1932x1916px, 45° FOV.
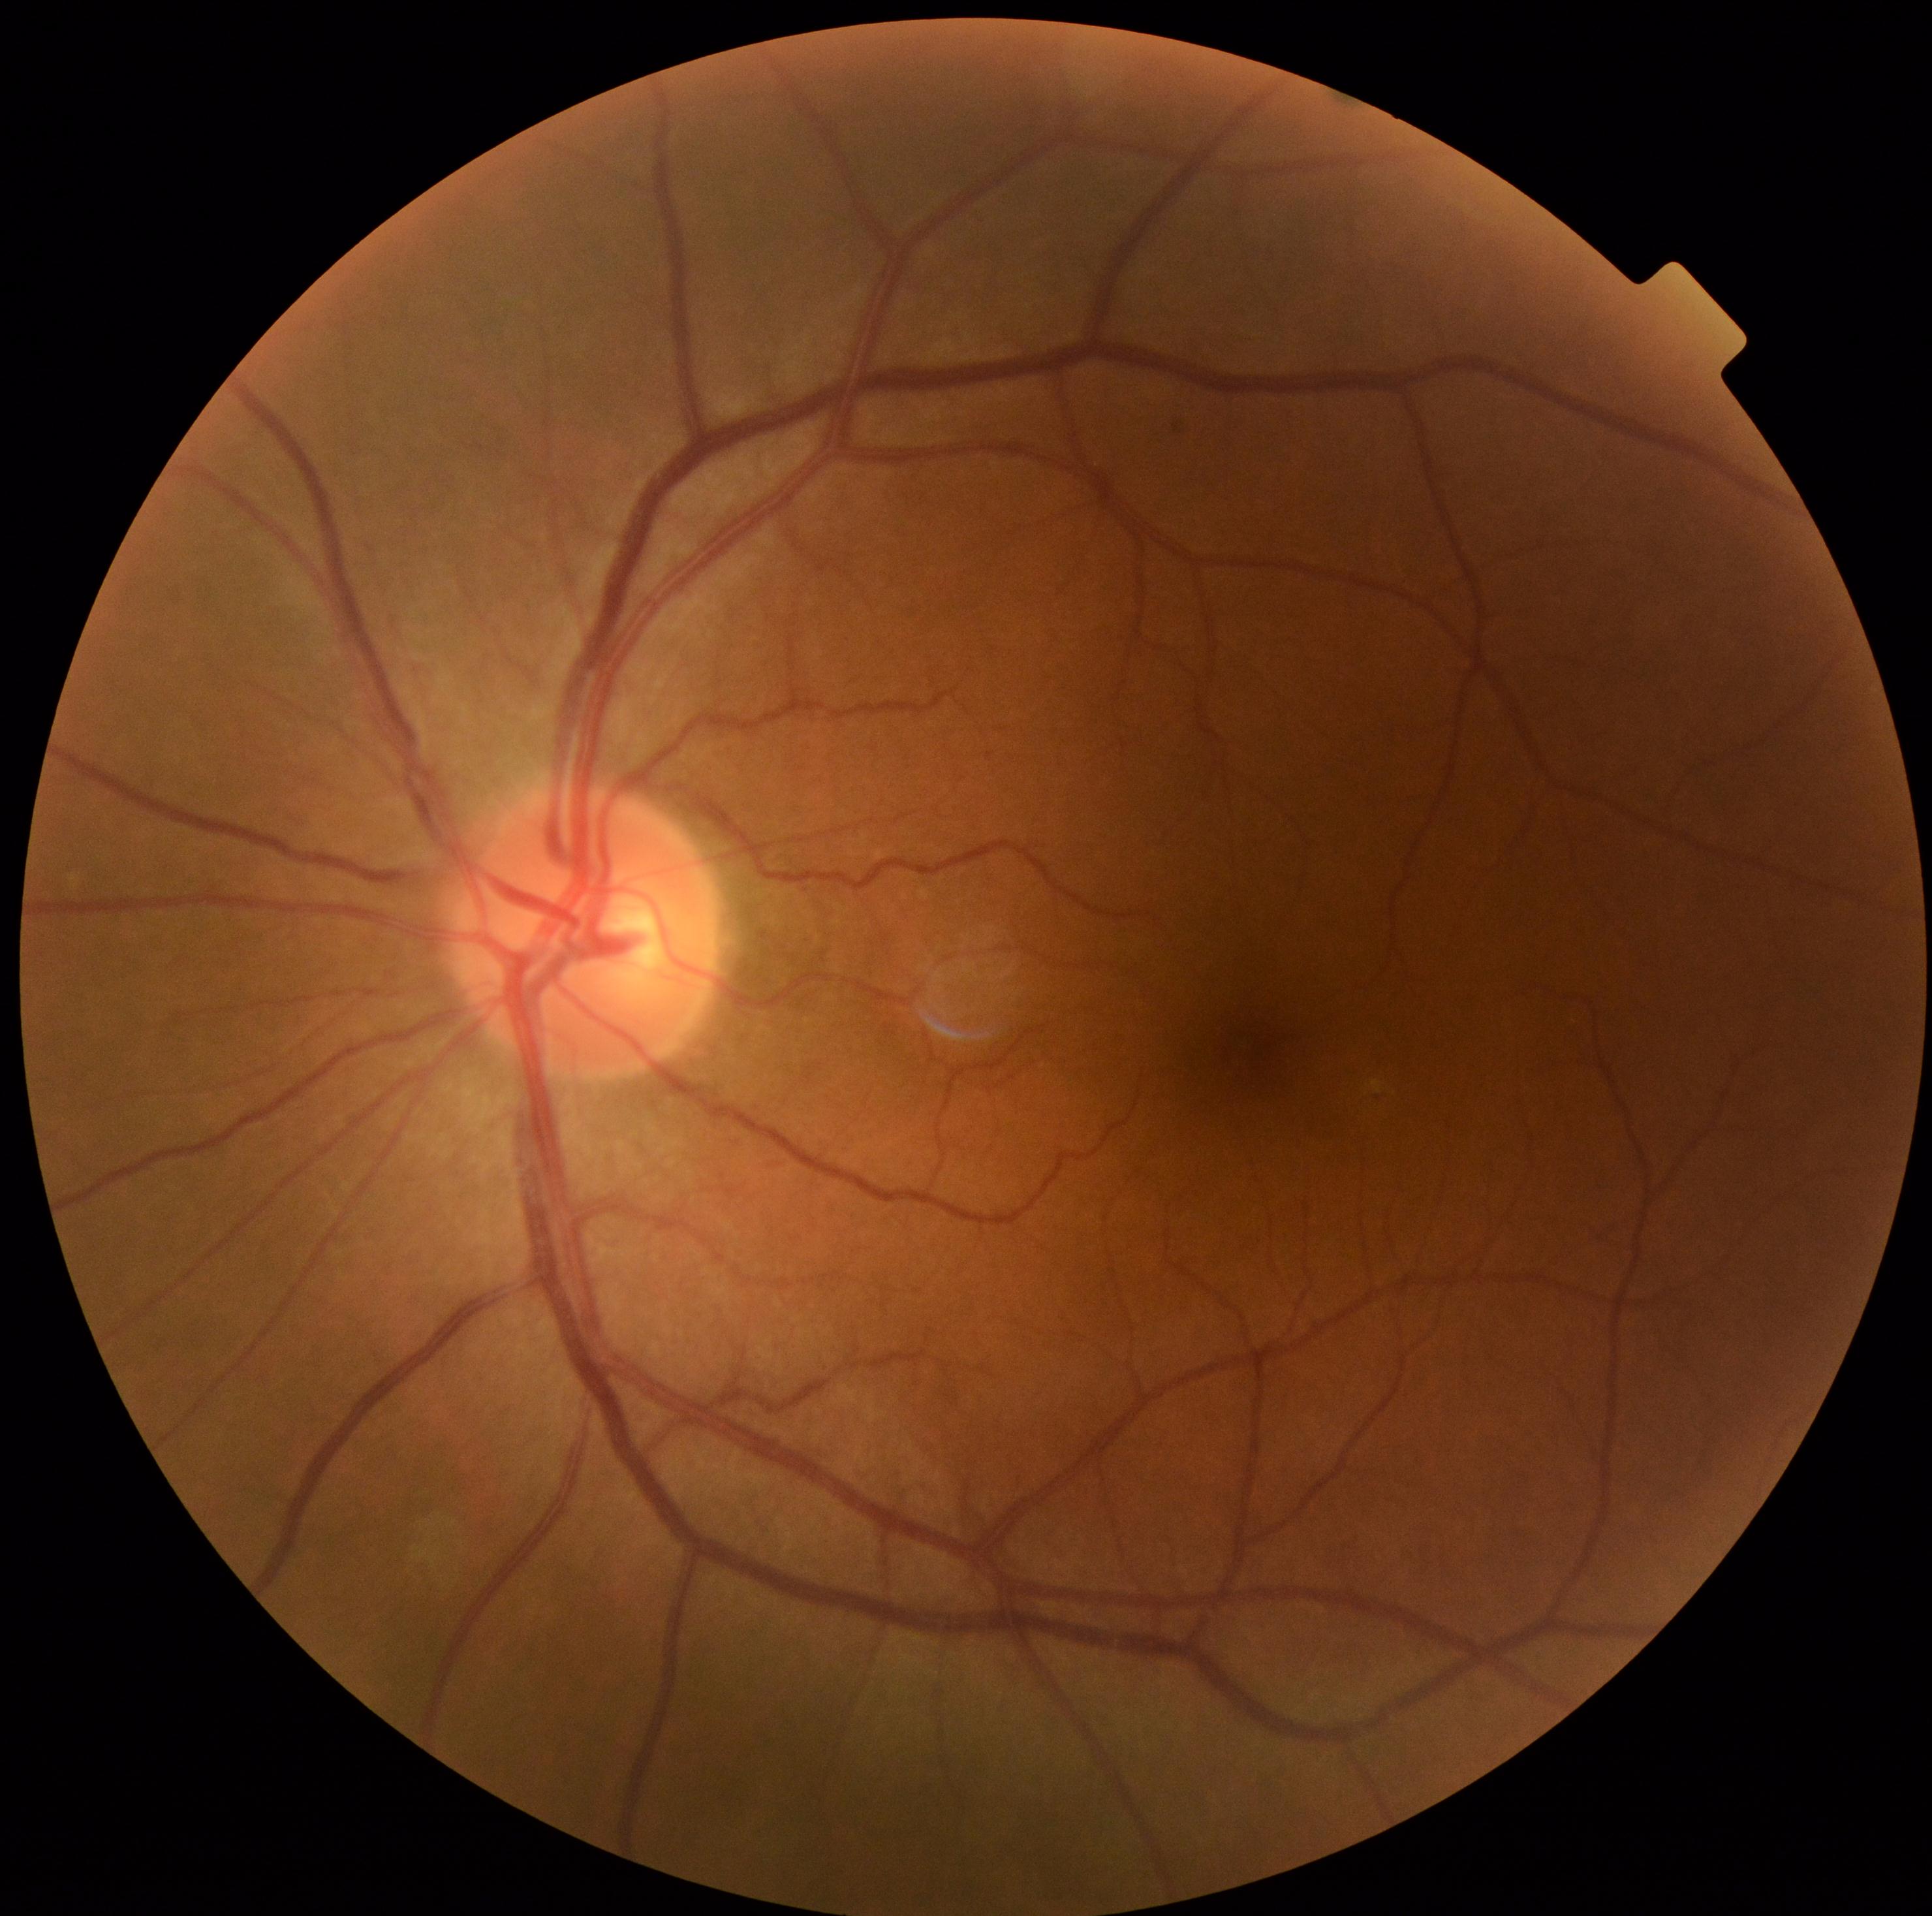

  dr_grade: 0